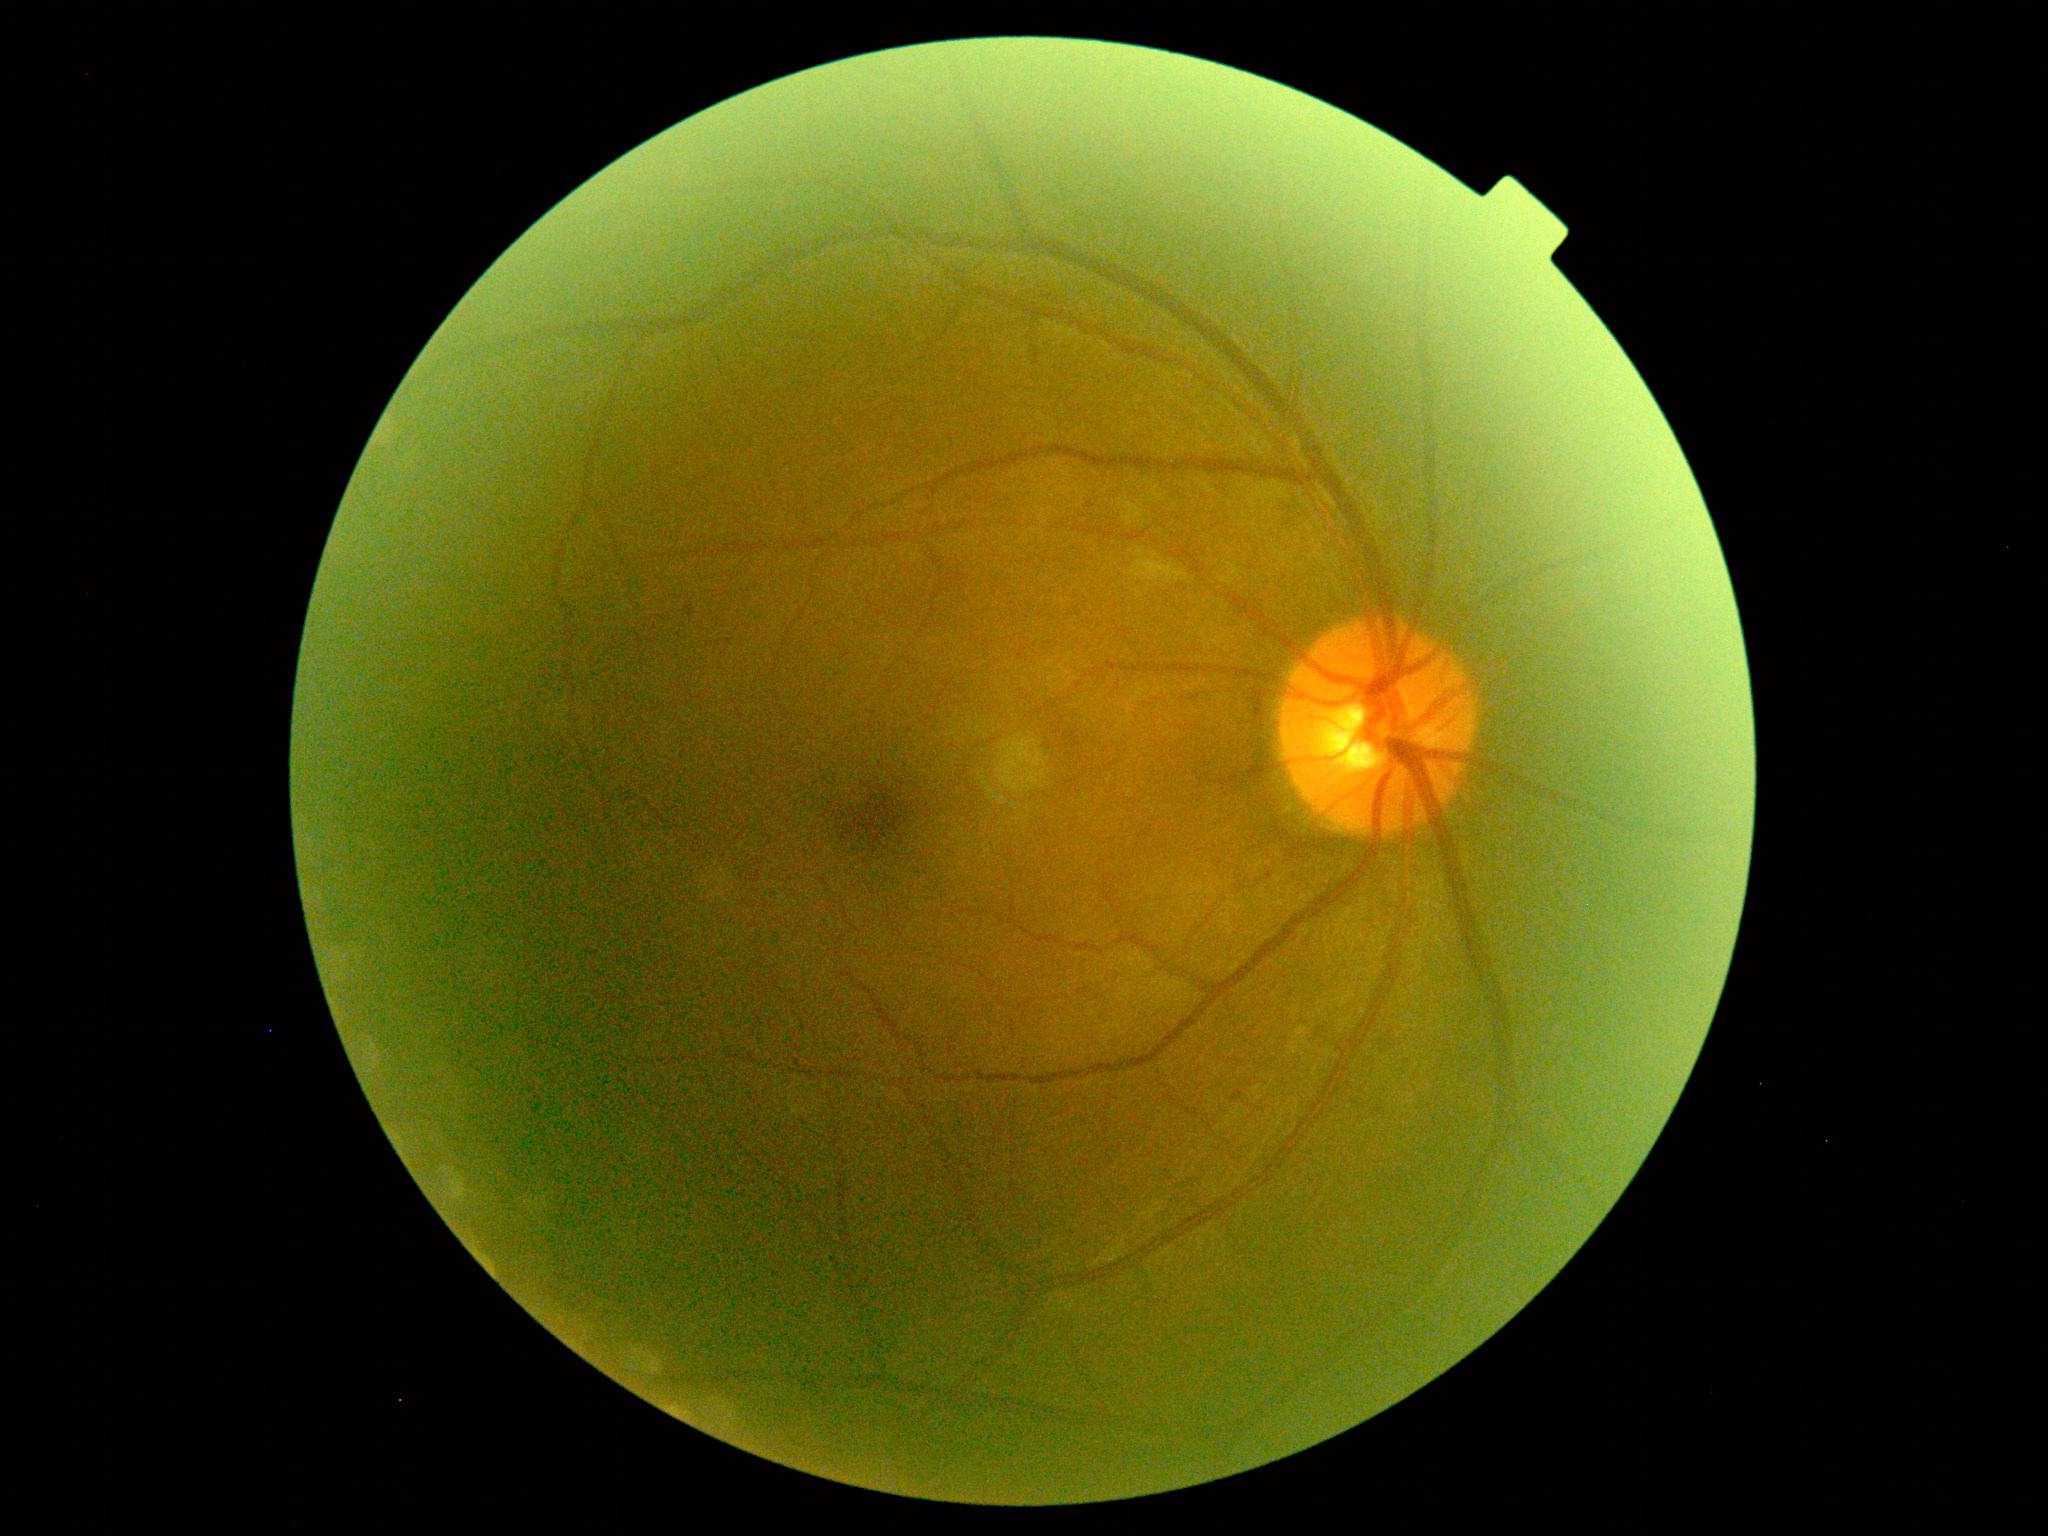
Diabetic retinopathy grade is 2.